CFP · 45° field of view · 2212 by 1659 pixels.
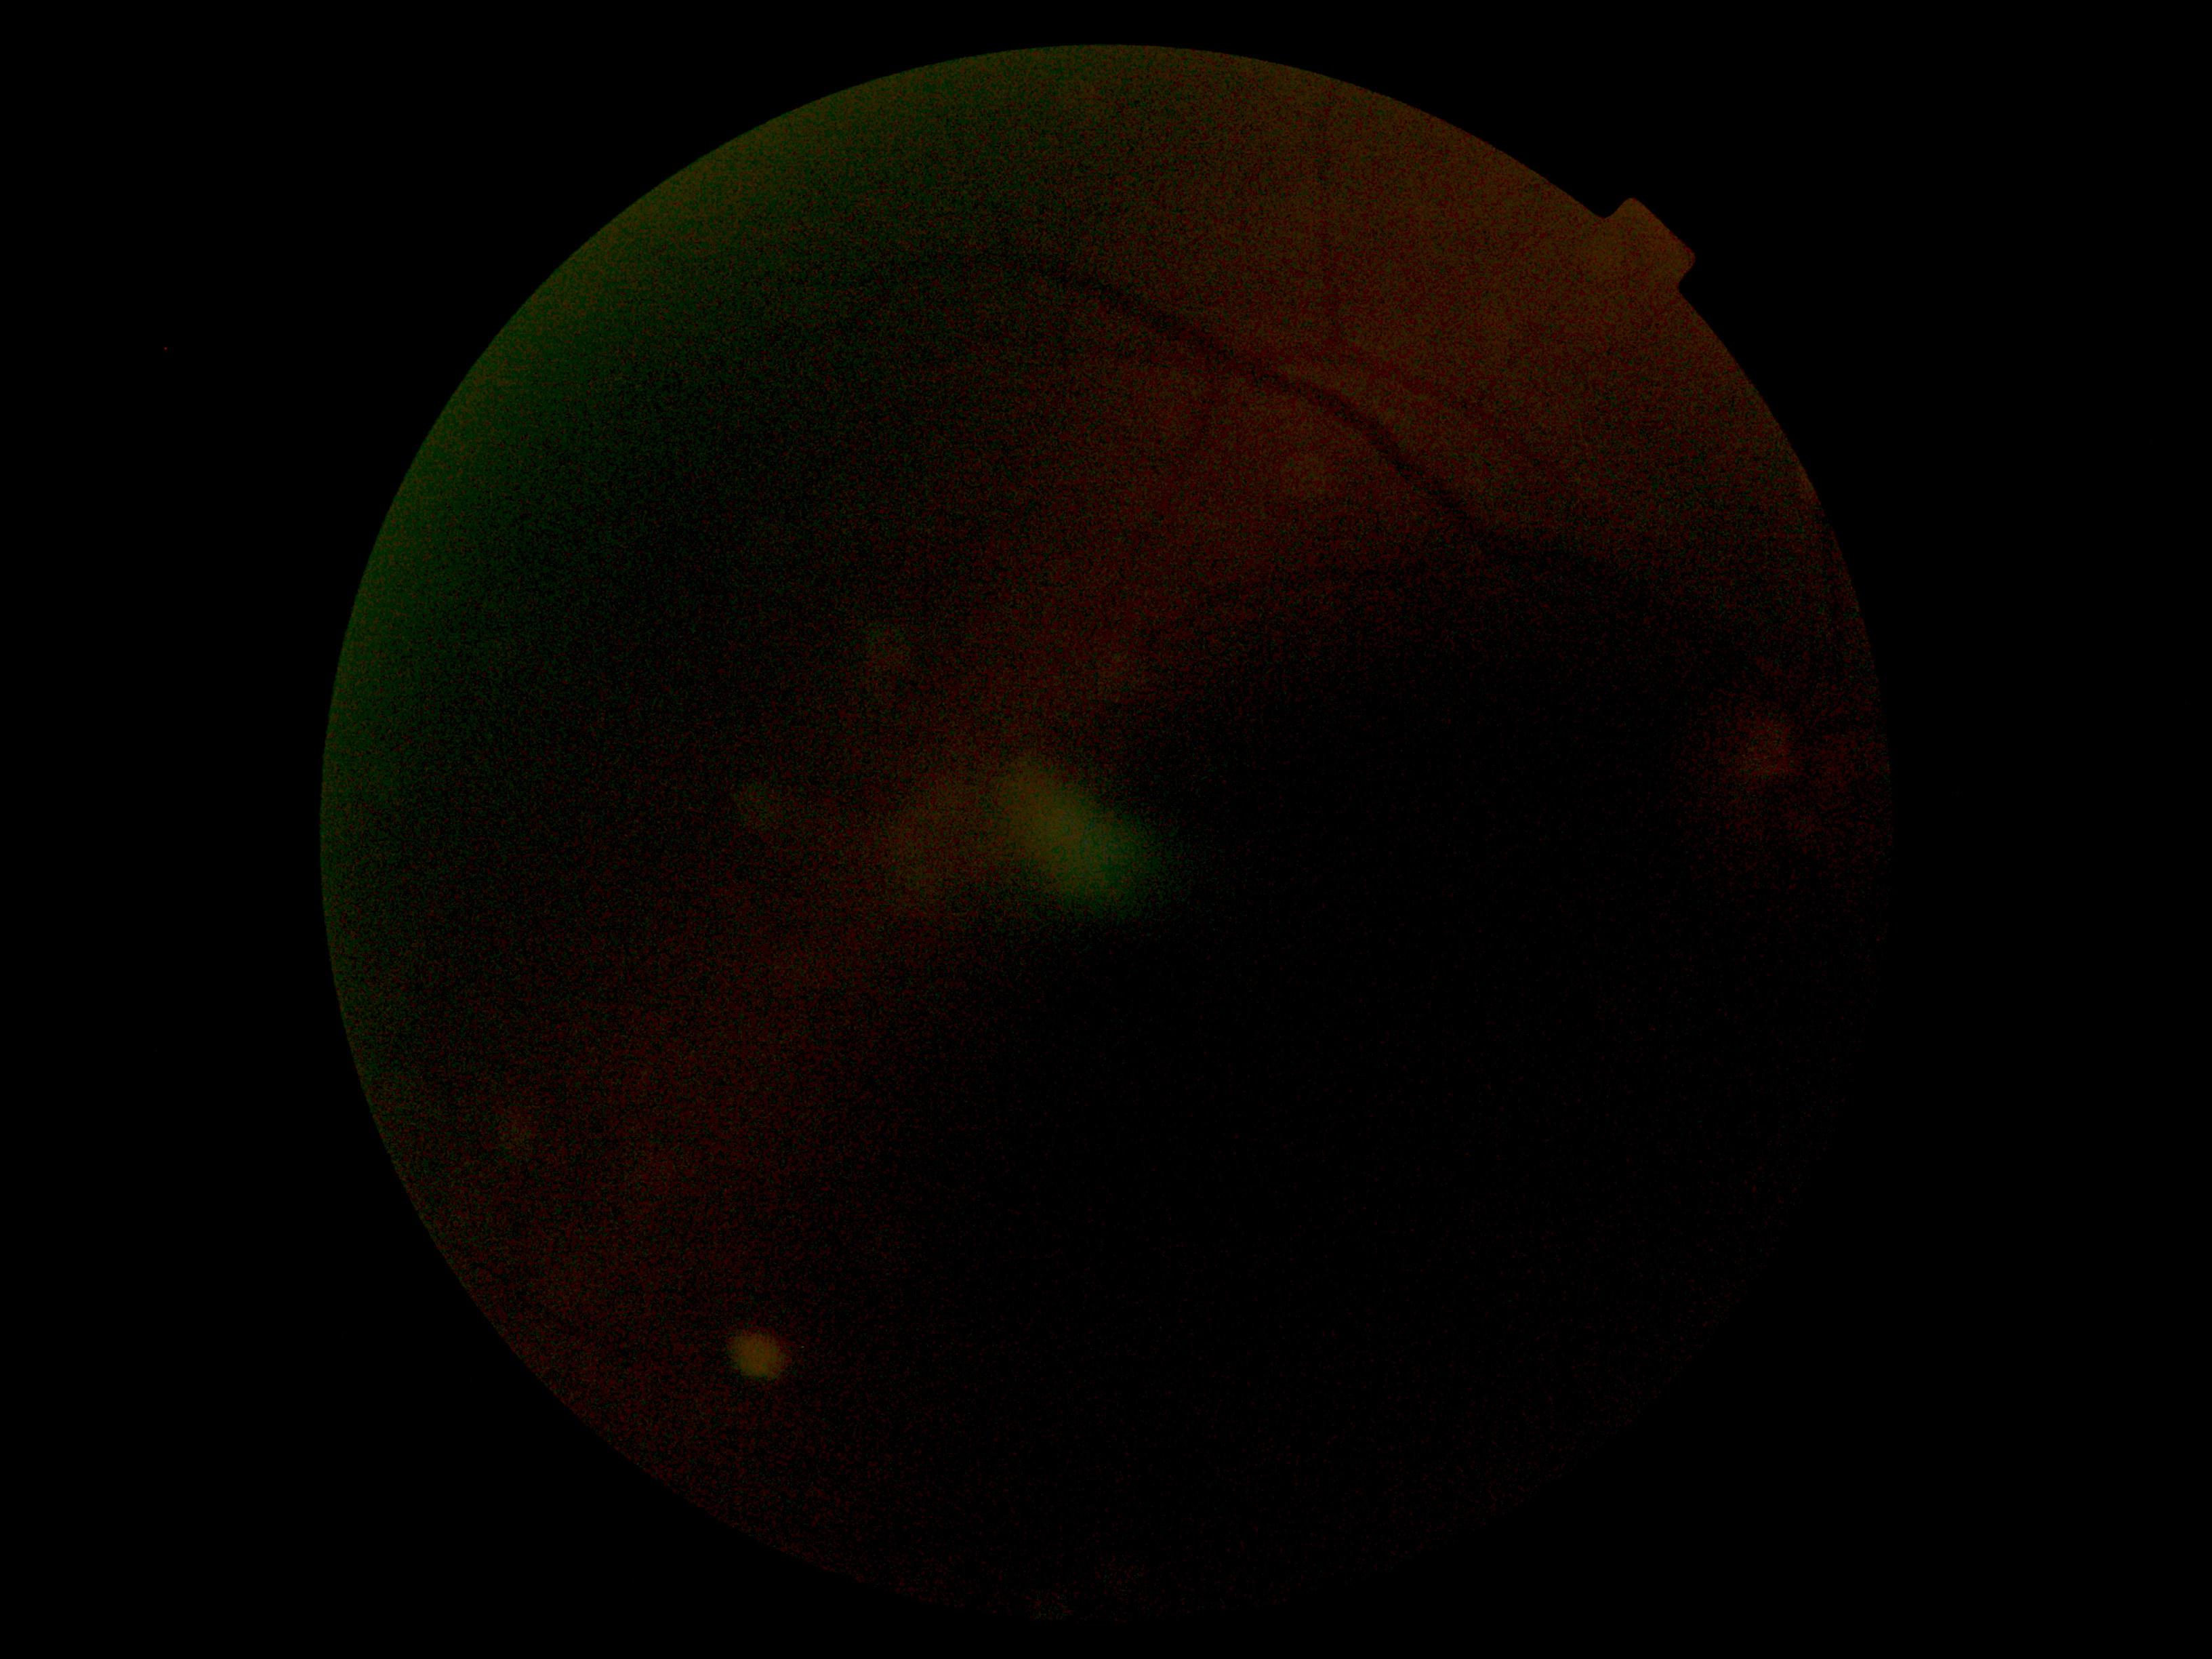 DR: ungradable.